50° field of view; image size 2361x1568; mydriatic (tropicamide 0.5%); retinal fundus photograph: 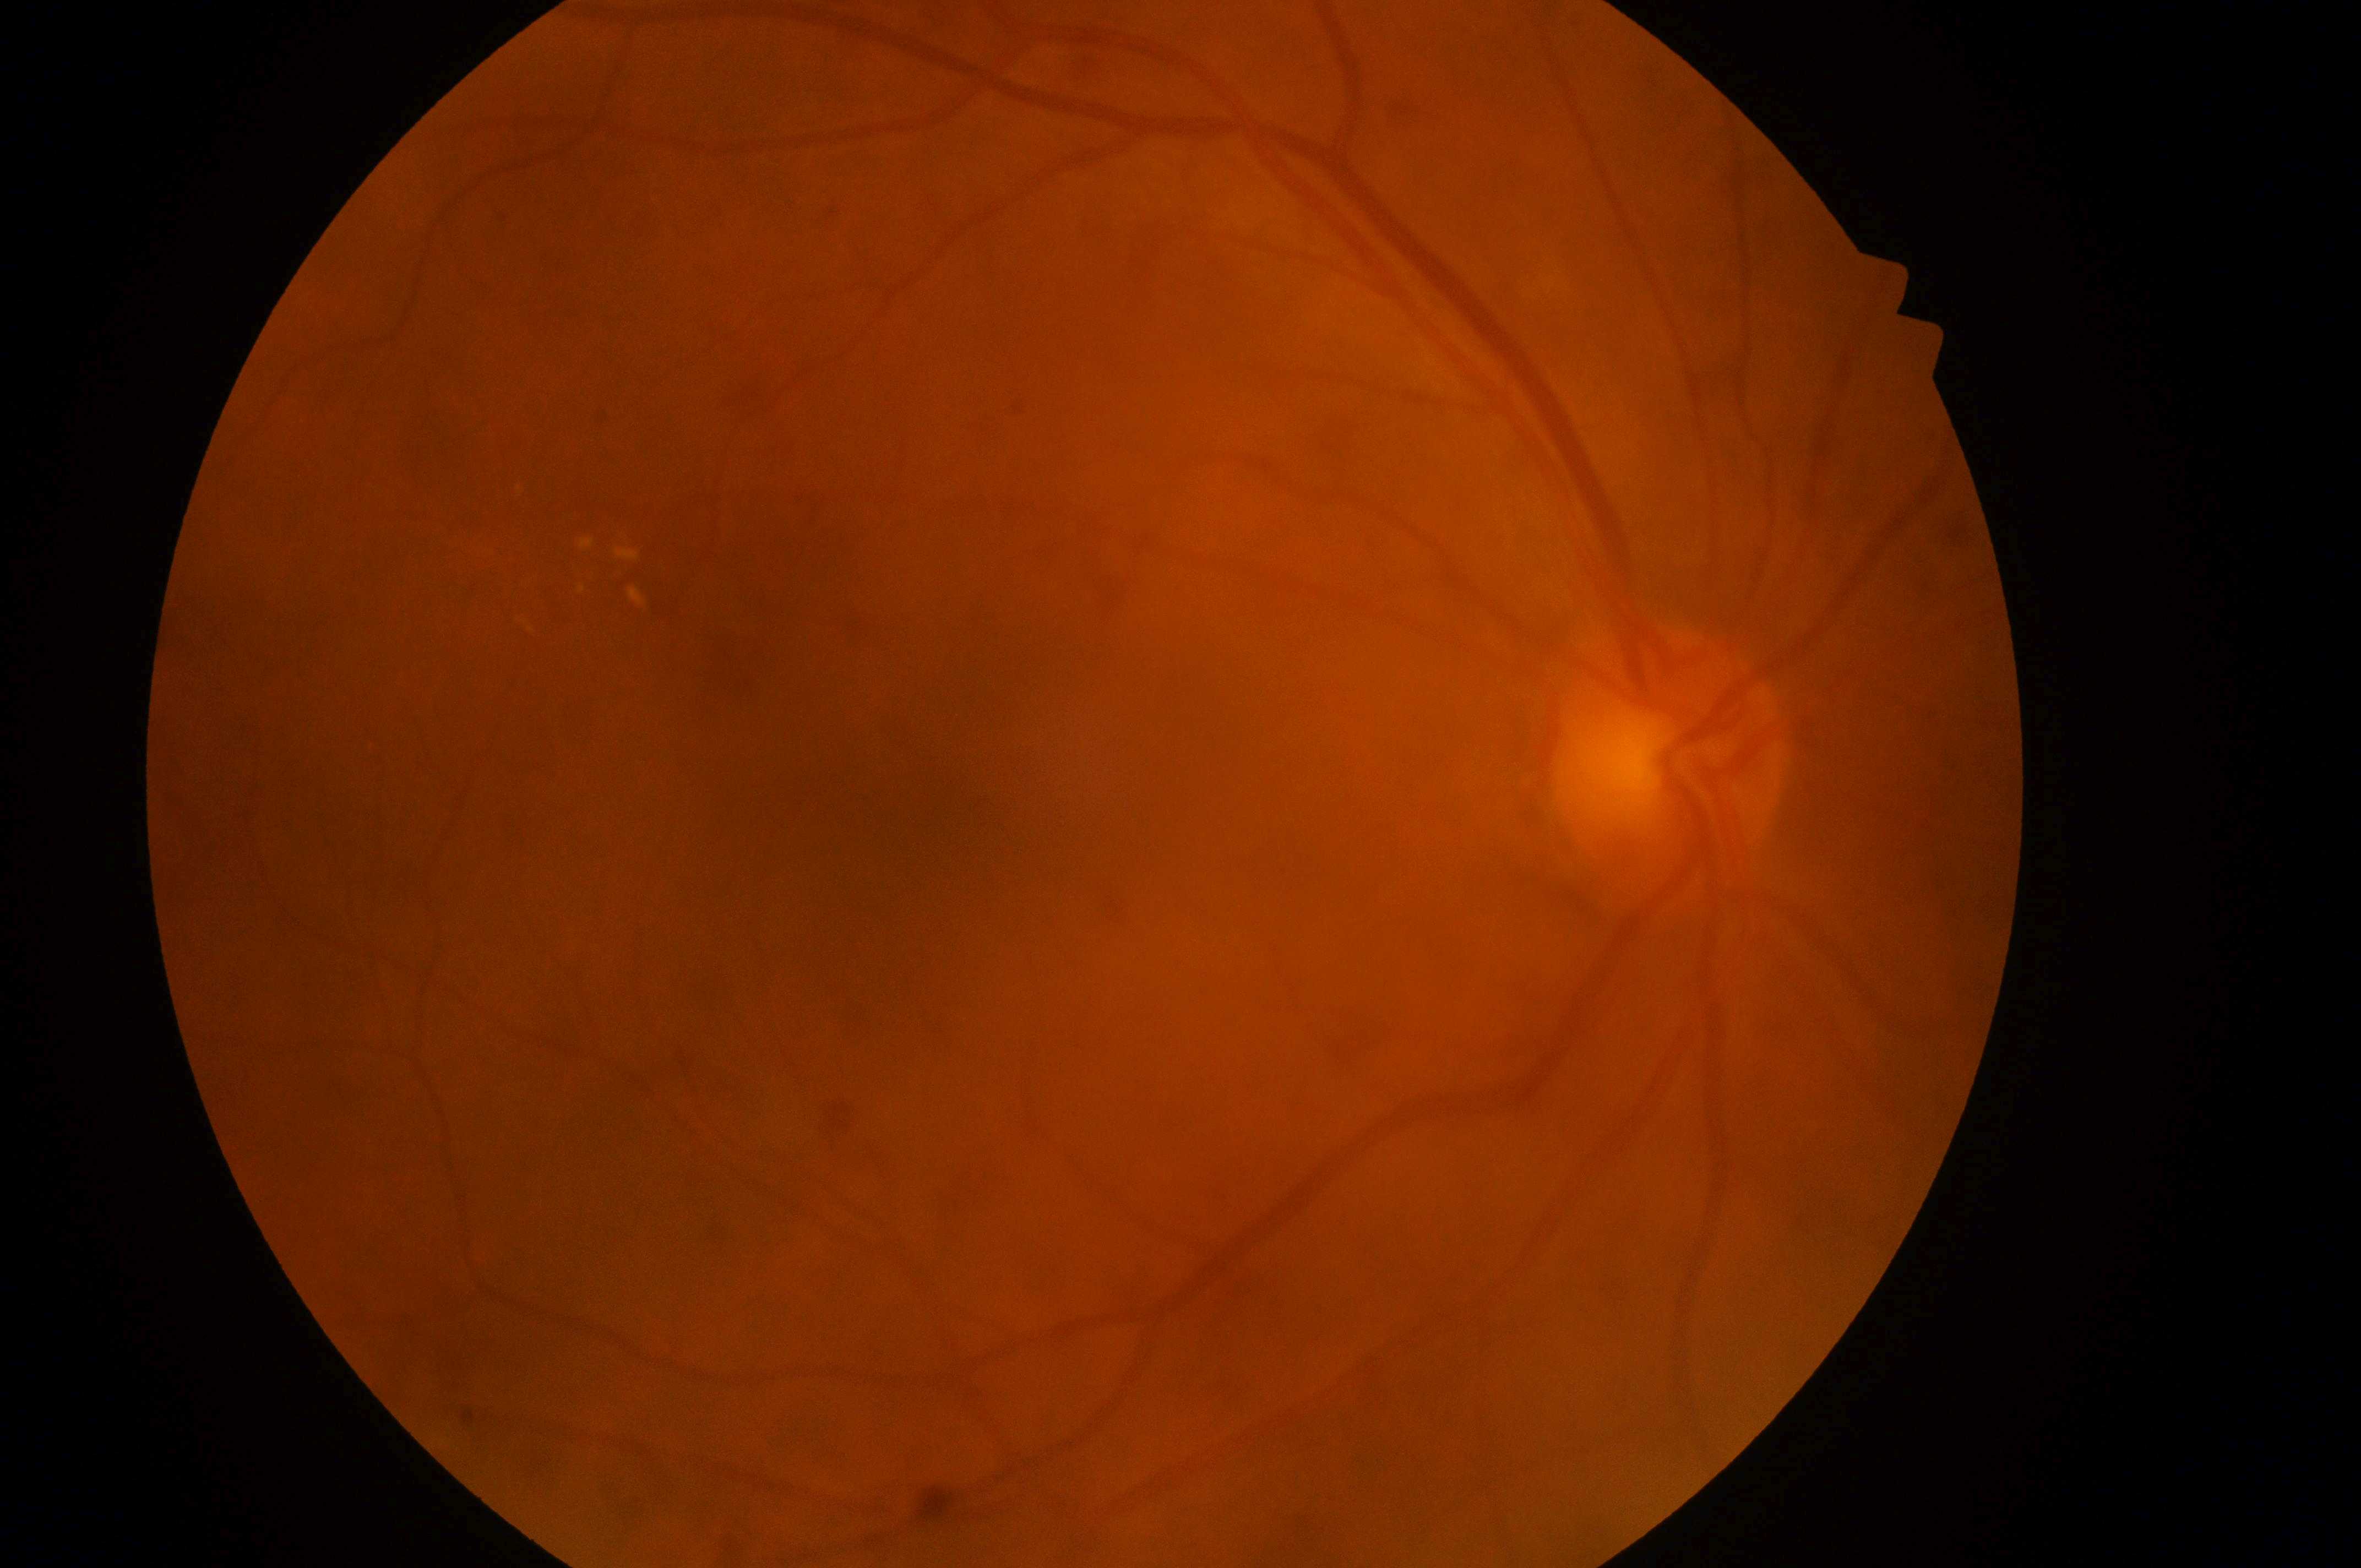
Diabetic retinopathy severity: grade 2 (moderate NPDR). The optic disk is at [1664, 771]. Macular edema is grade 1 (low risk). The image shows the right eye. Fovea centralis located at [924, 829].